Fundus photo; 2089 by 1764 pixels — 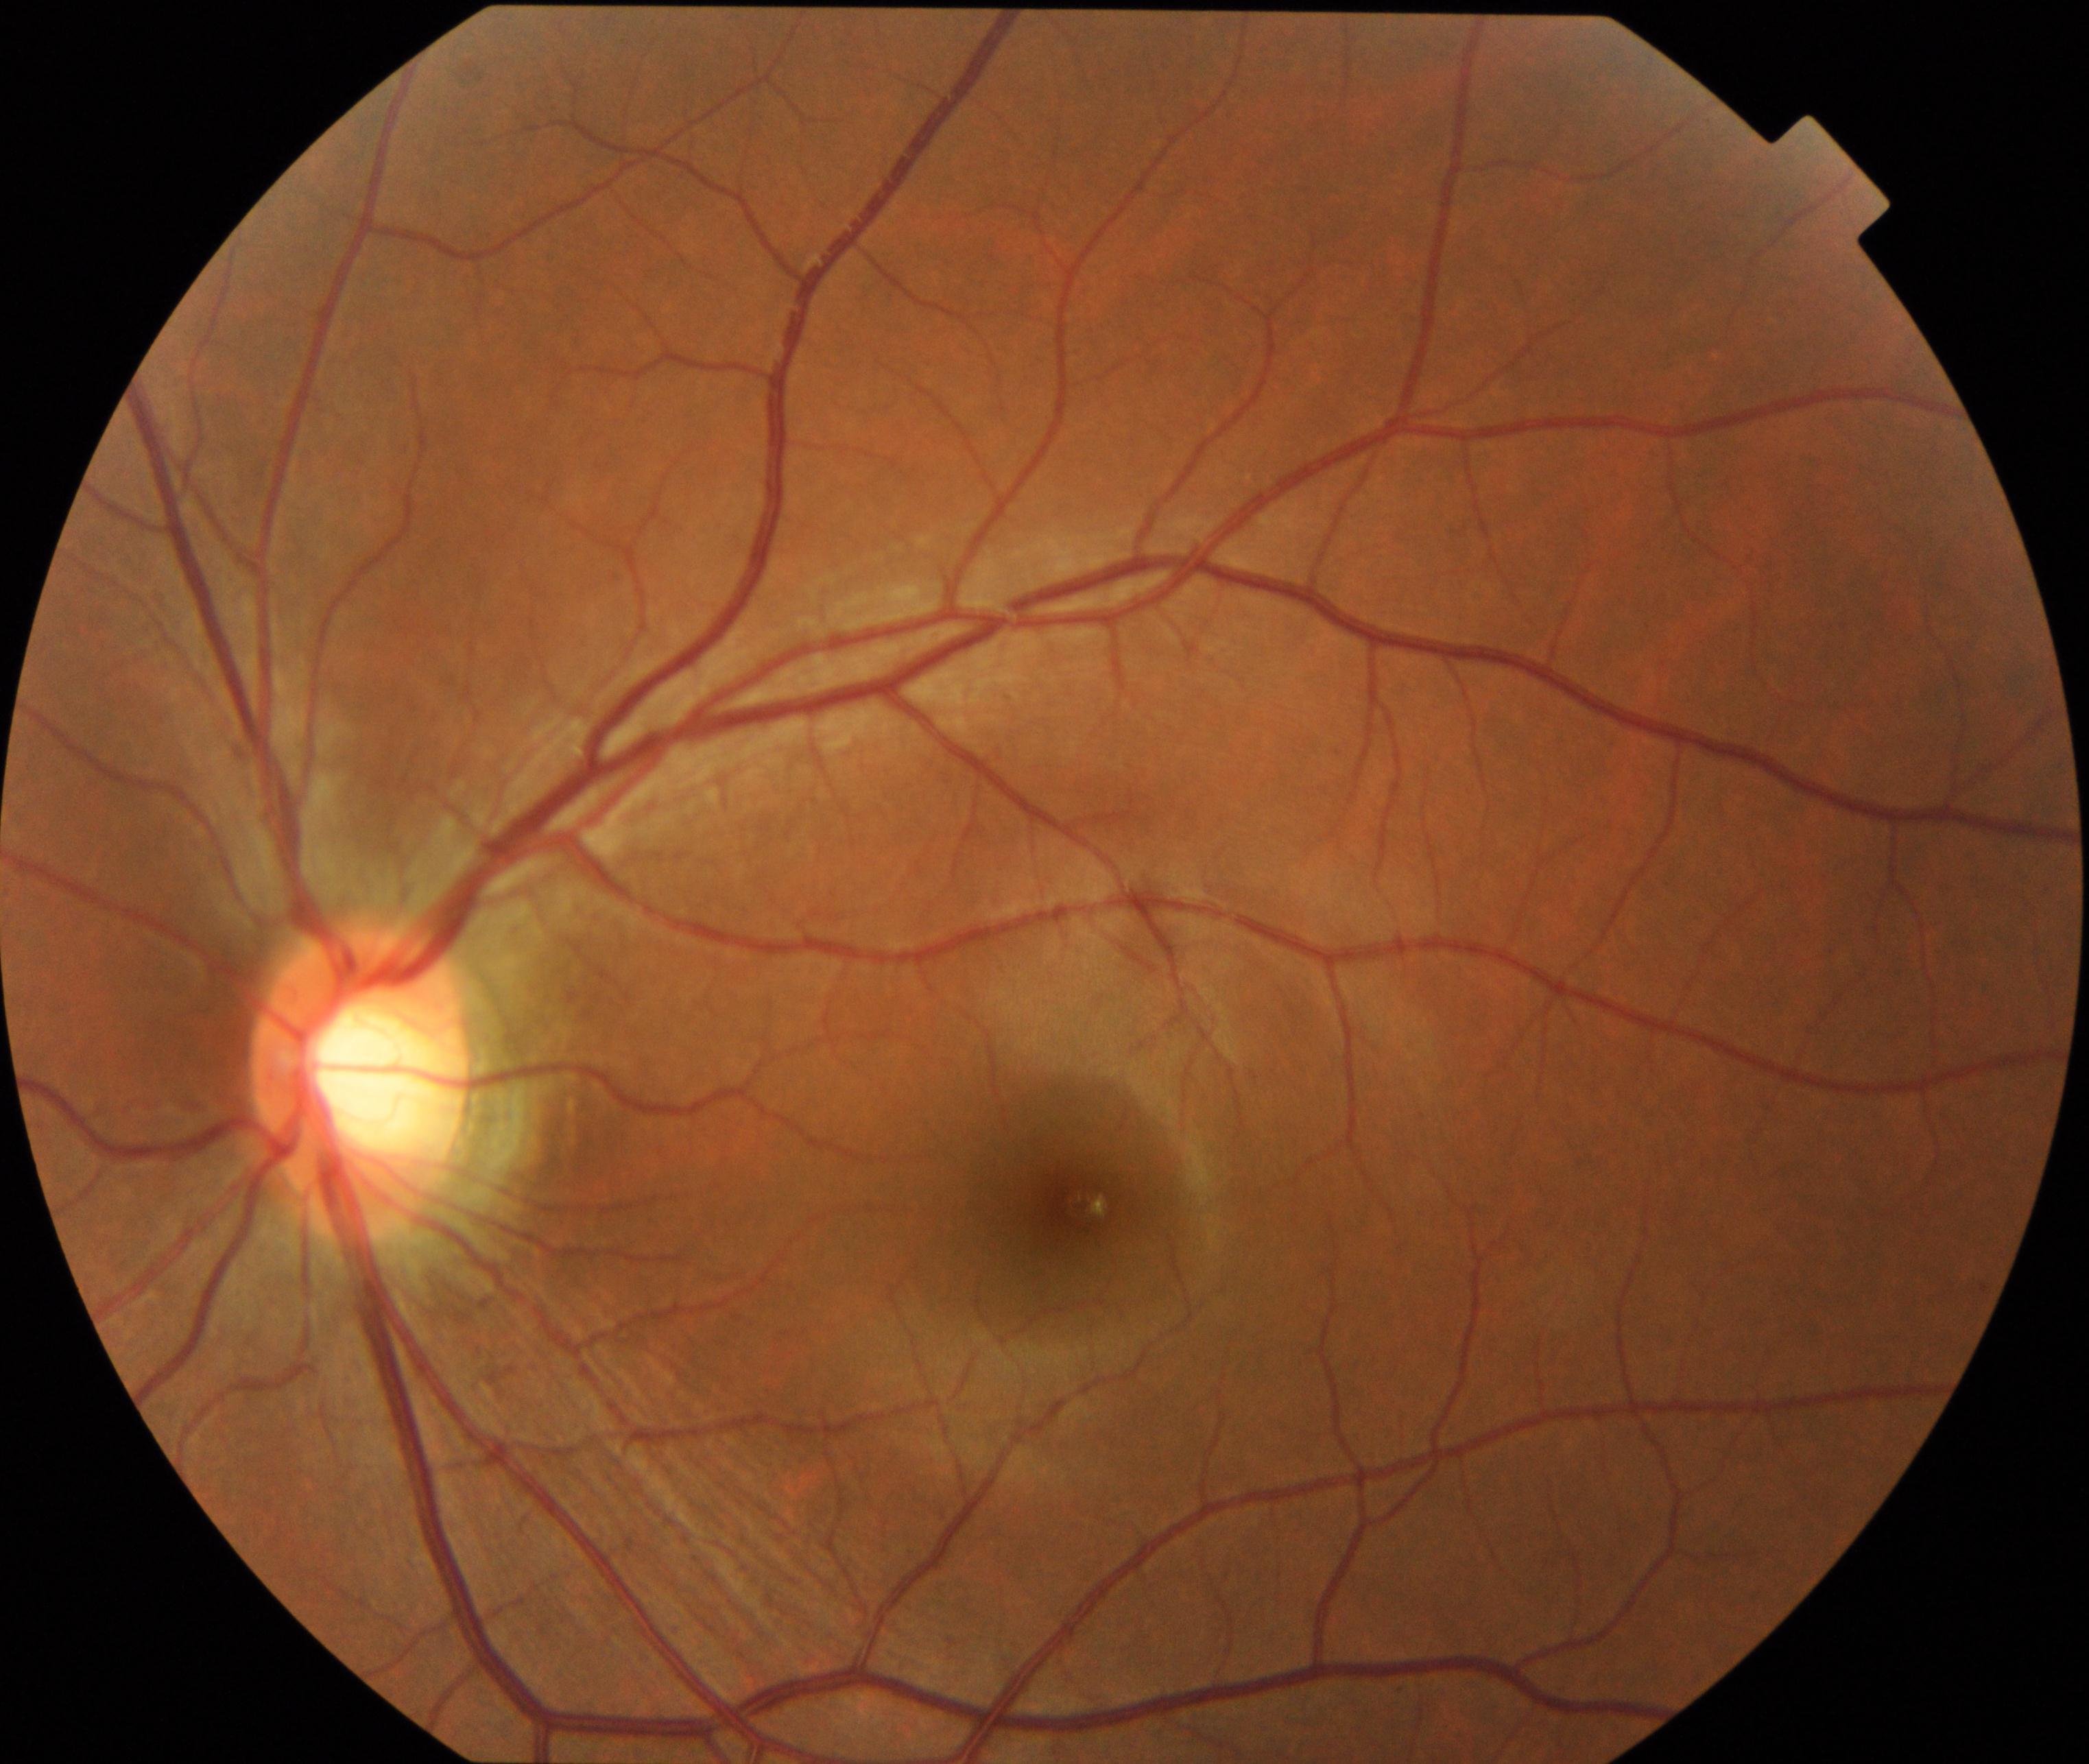 Demonstrates large optic cup.